Acquired with a Remidio FOP fundus camera. Color fundus image: 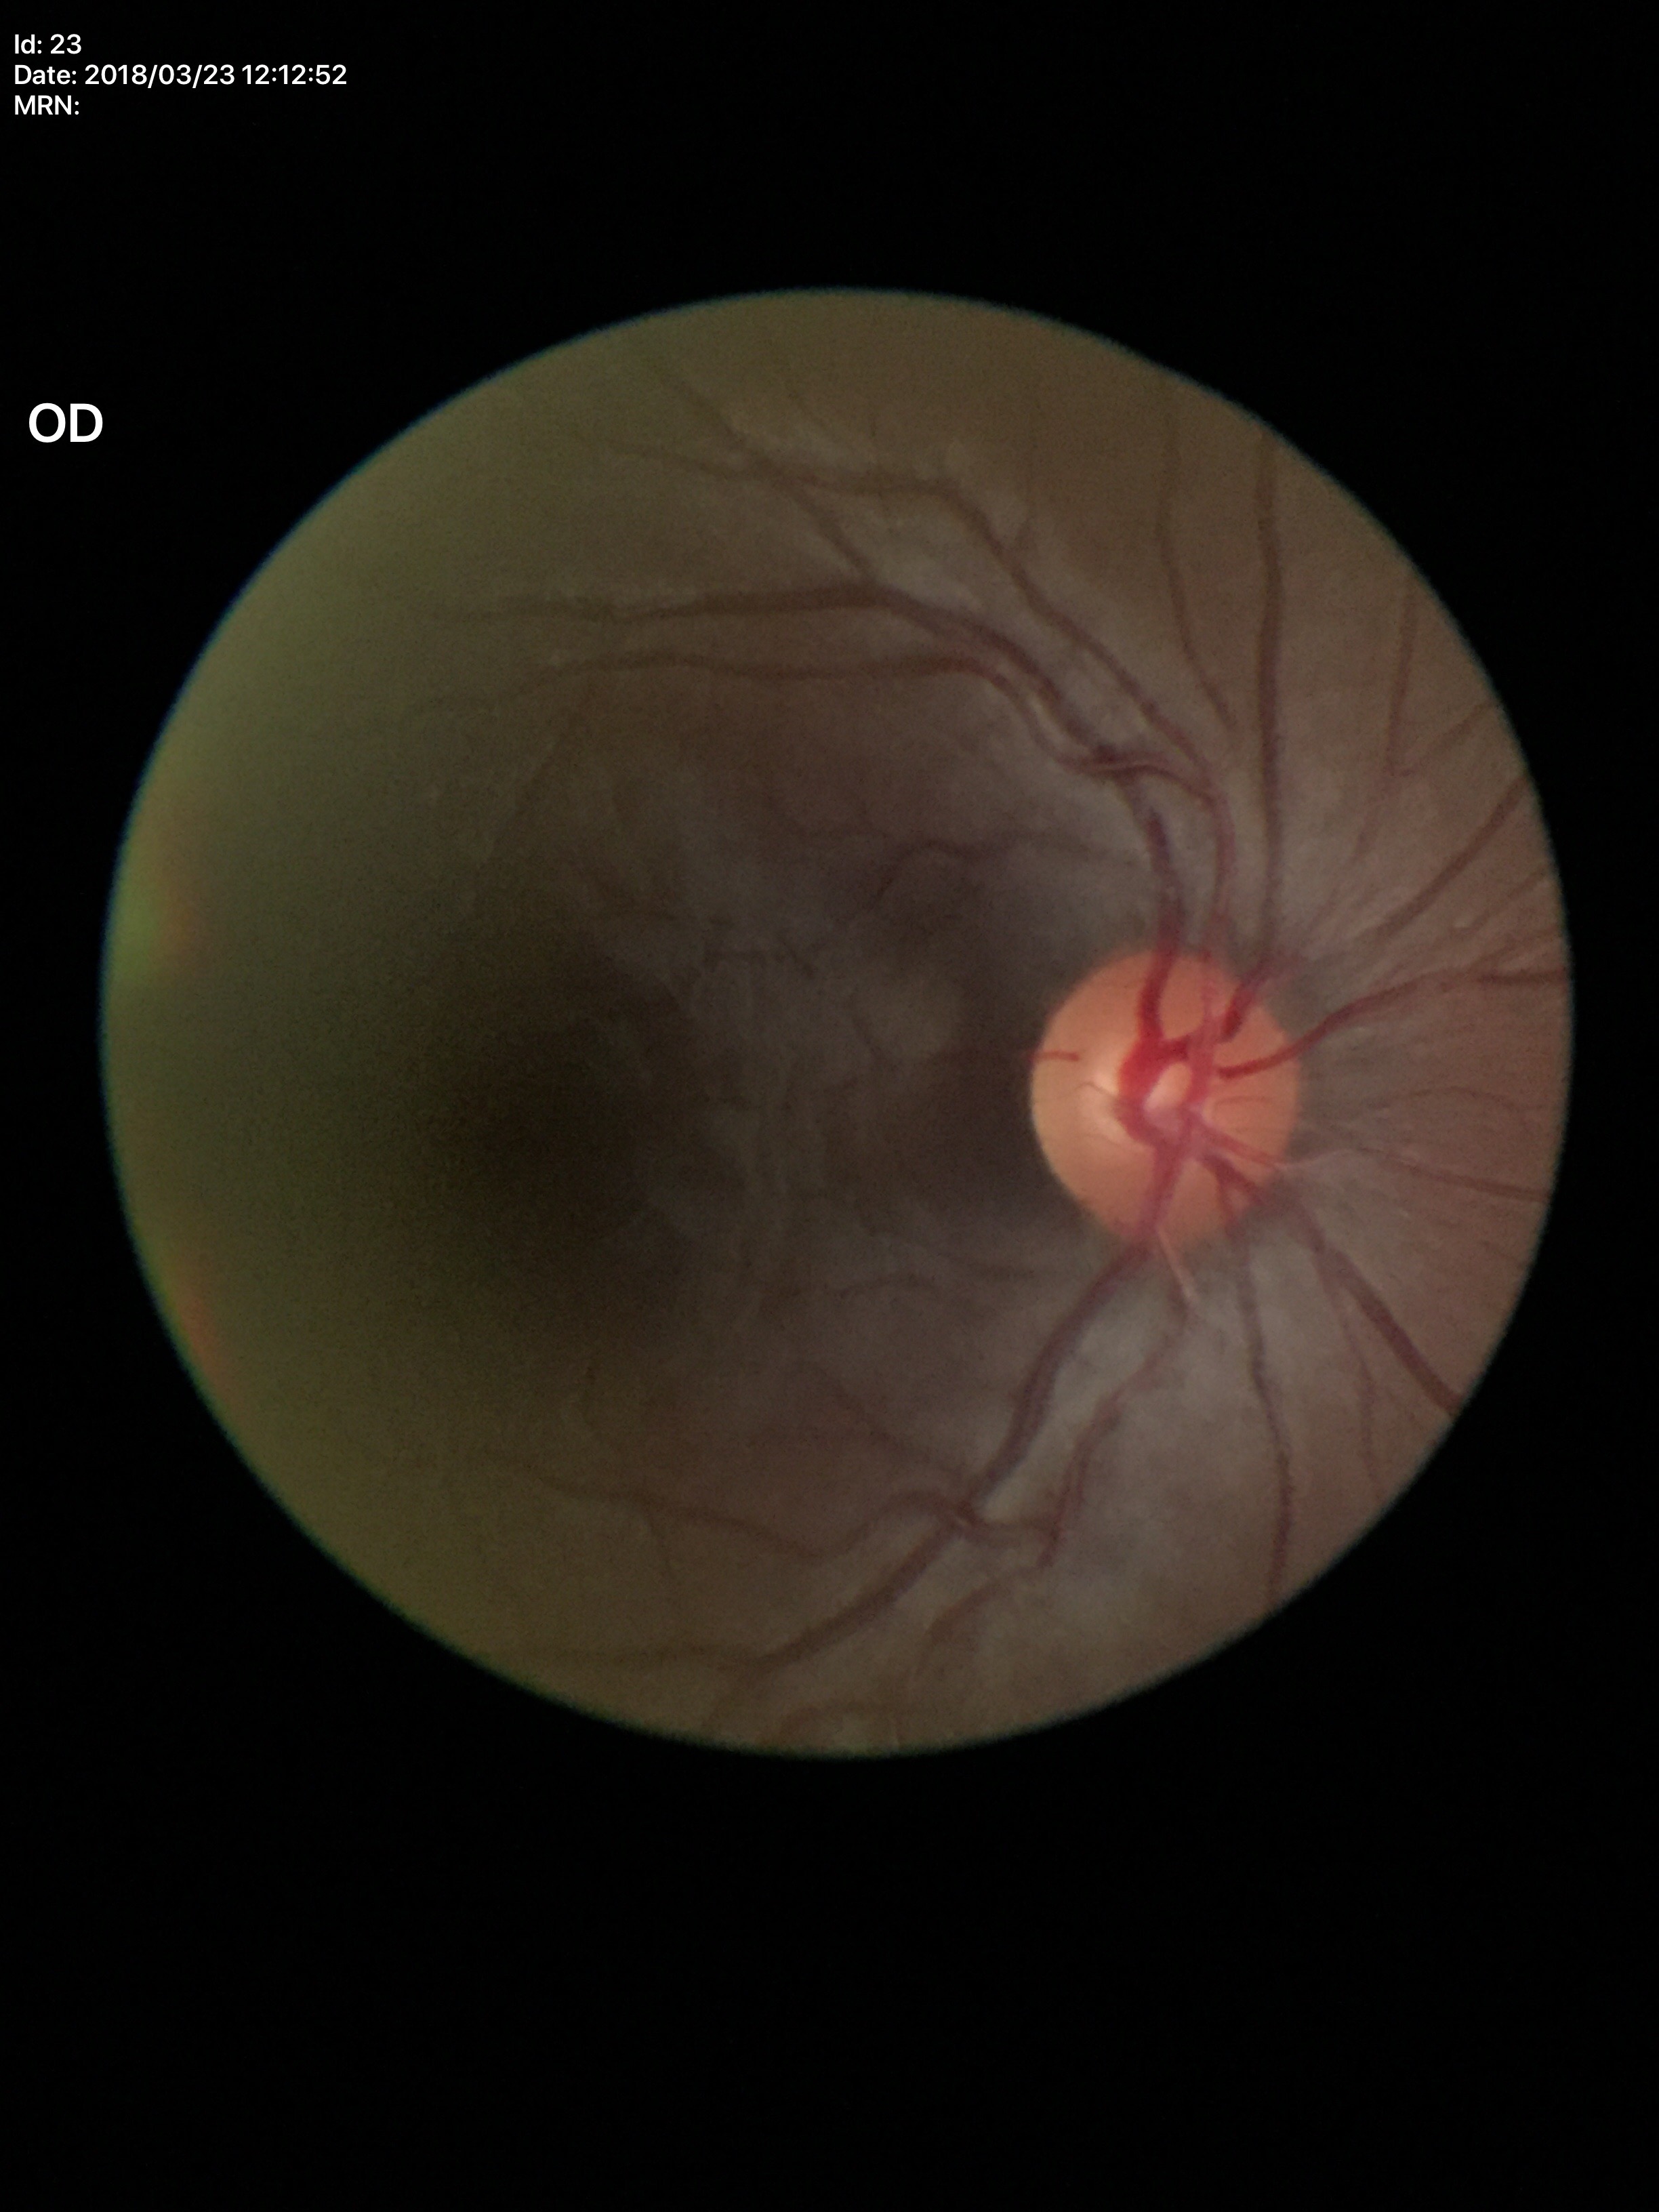

Glaucoma impression = no suspicious findings | vertical C/D ratio = 0.55 | area CDR = 0.31 | horizontal cup-disc ratio = 0.55.